Wide-field contact fundus photograph of an infant; 640 by 480 pixels: 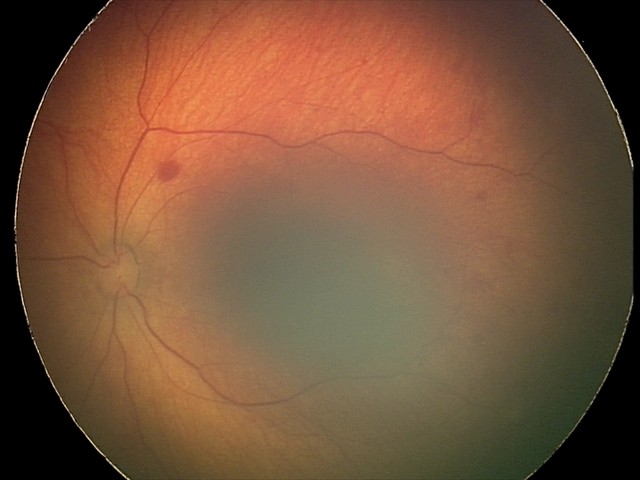
Assessment: retinal hemorrhages.